CFP: 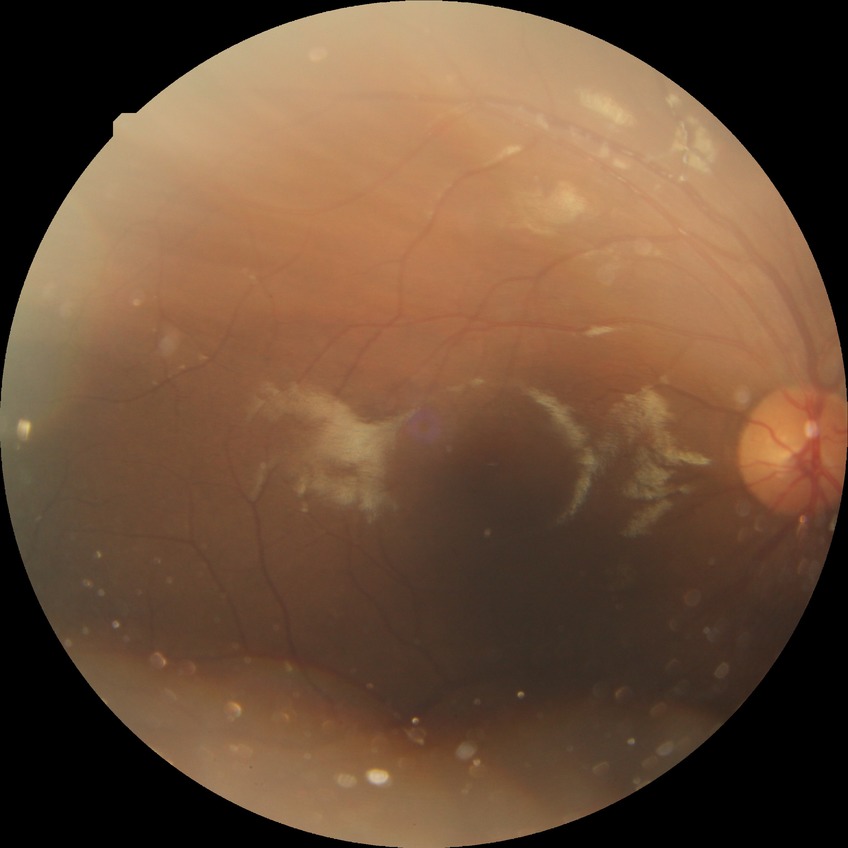
{"davis_grade": "no diabetic retinopathy"}